Davis DR grading.
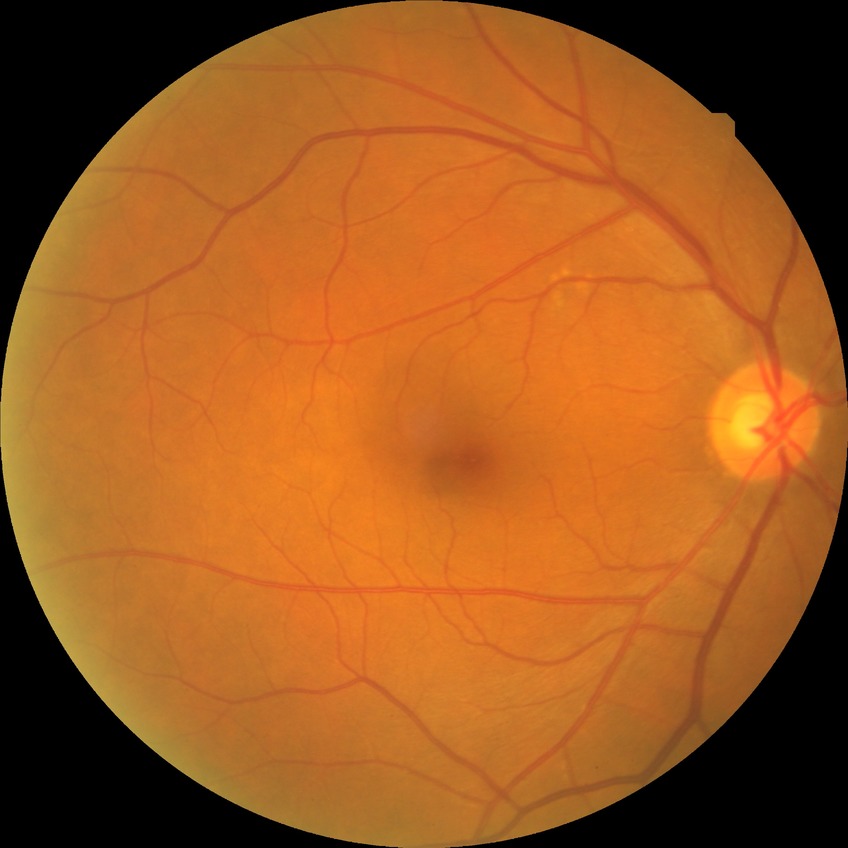 Diabetic retinopathy (DR): SDR (simple diabetic retinopathy).